DR severity per modified Davis staging: 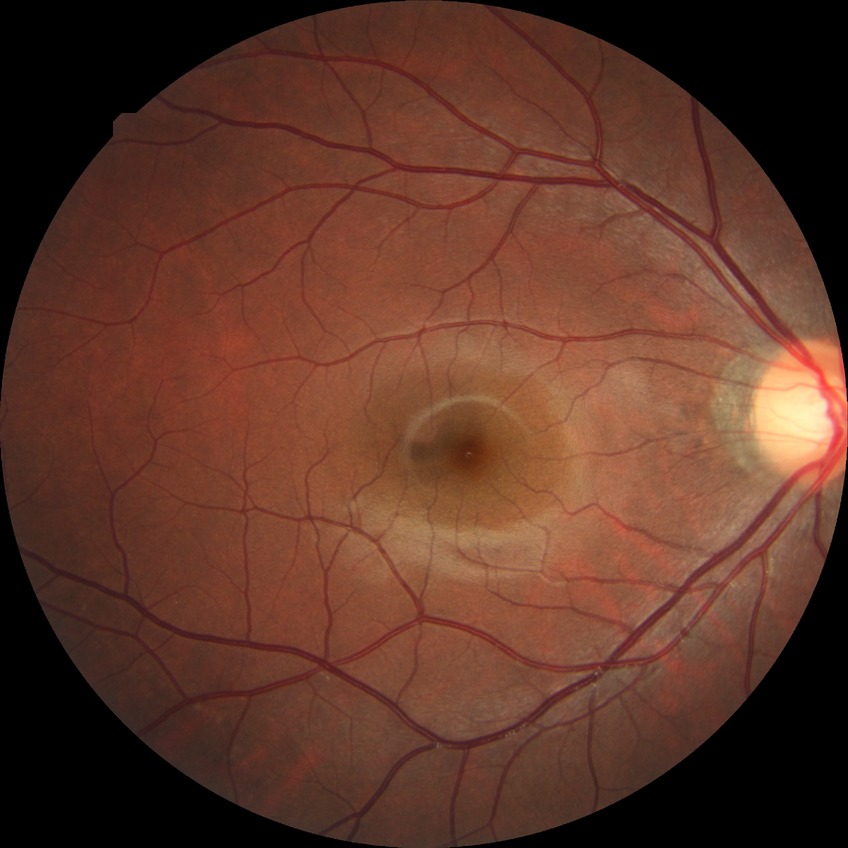
Davis stage = NDR.